Color fundus image:
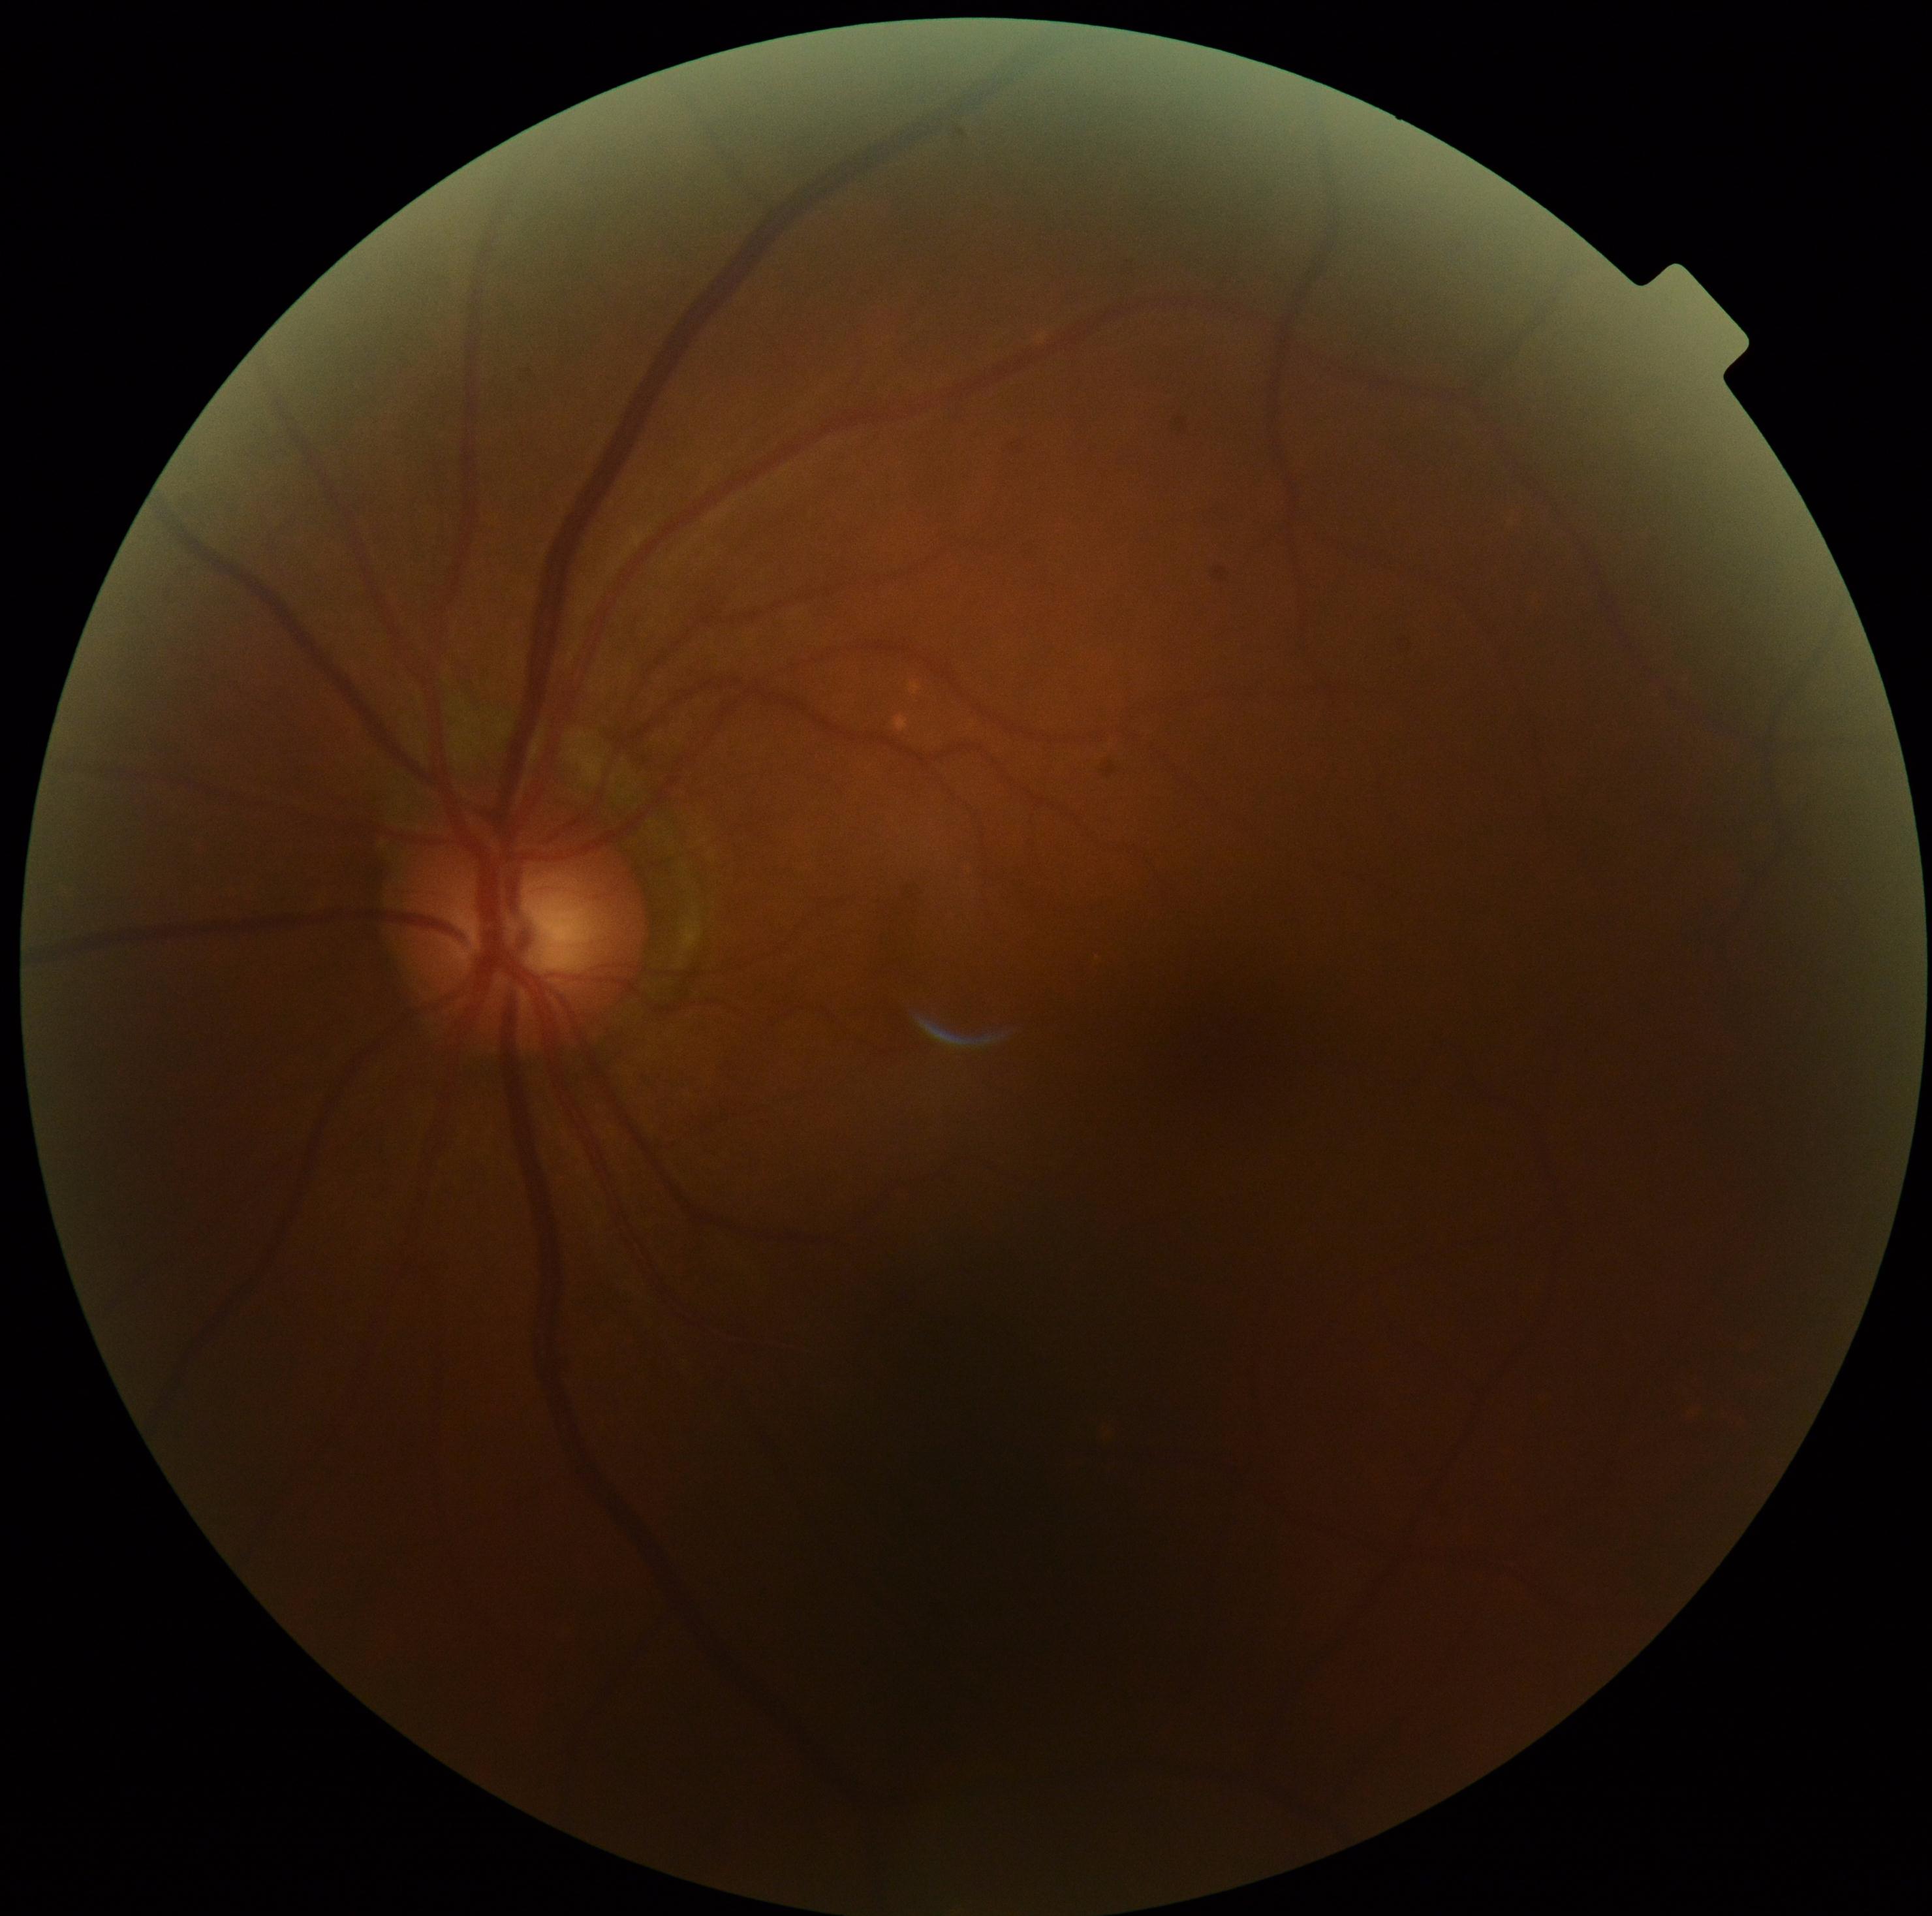
Findings:
* DR impression: no DR findings
* diabetic retinopathy (DR): no apparent retinopathy (grade 0)